Infant wide-field retinal image — 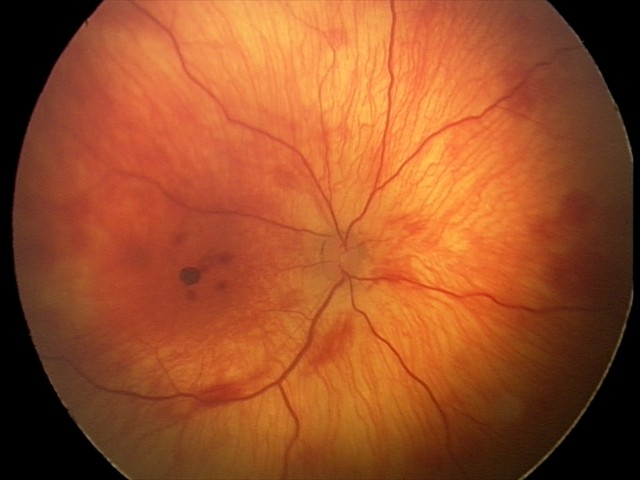
Screening series with retinal hemorrhages.